Camera: Phoenix ICON (100° FOV). Pediatric retinal photograph (wide-field) — 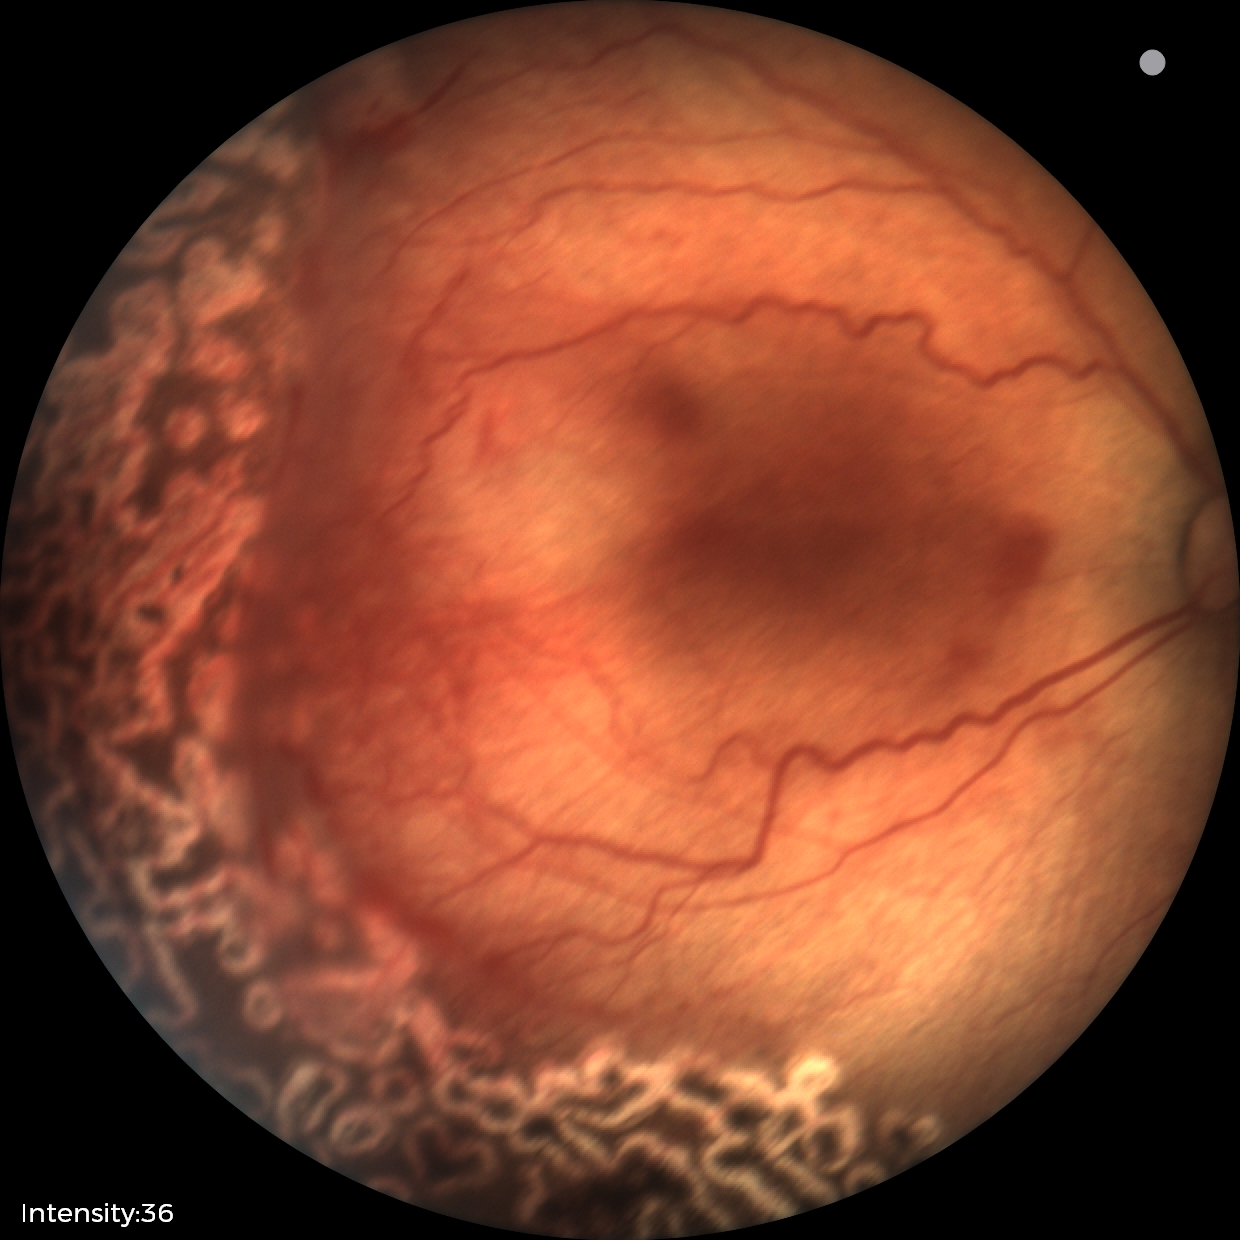
Q: What is the diagnosis from this examination?
A: status post retinopathy of prematurity (ROP)